848 by 848 pixels. Modified Davis grading:
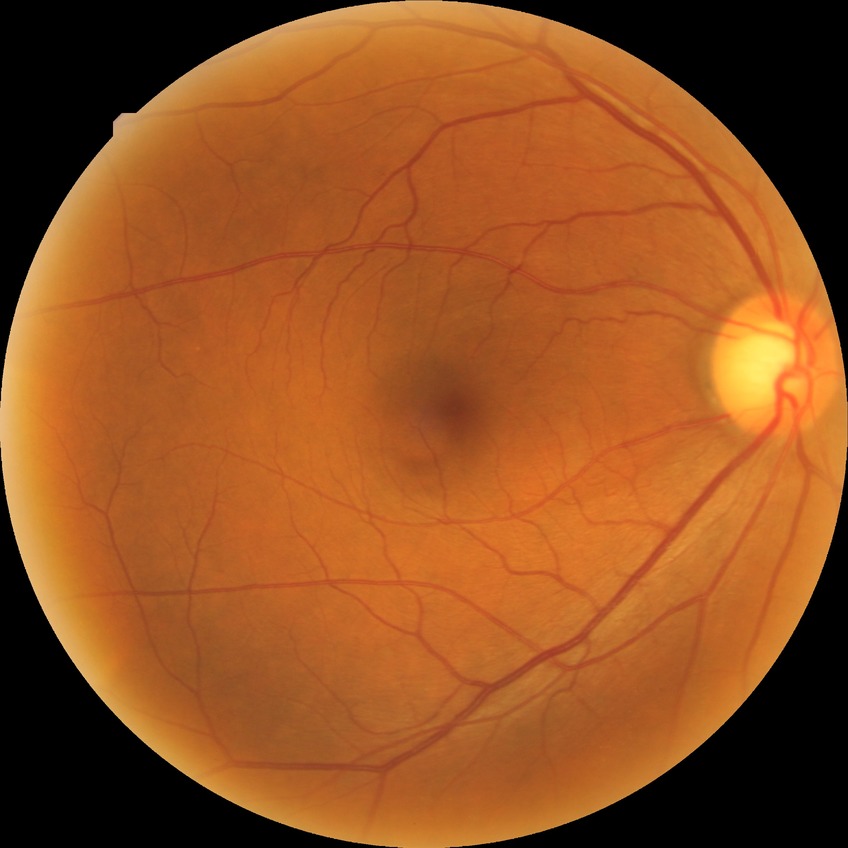

diabetic retinopathy (DR) = NDR (no diabetic retinopathy).